1659x2212.
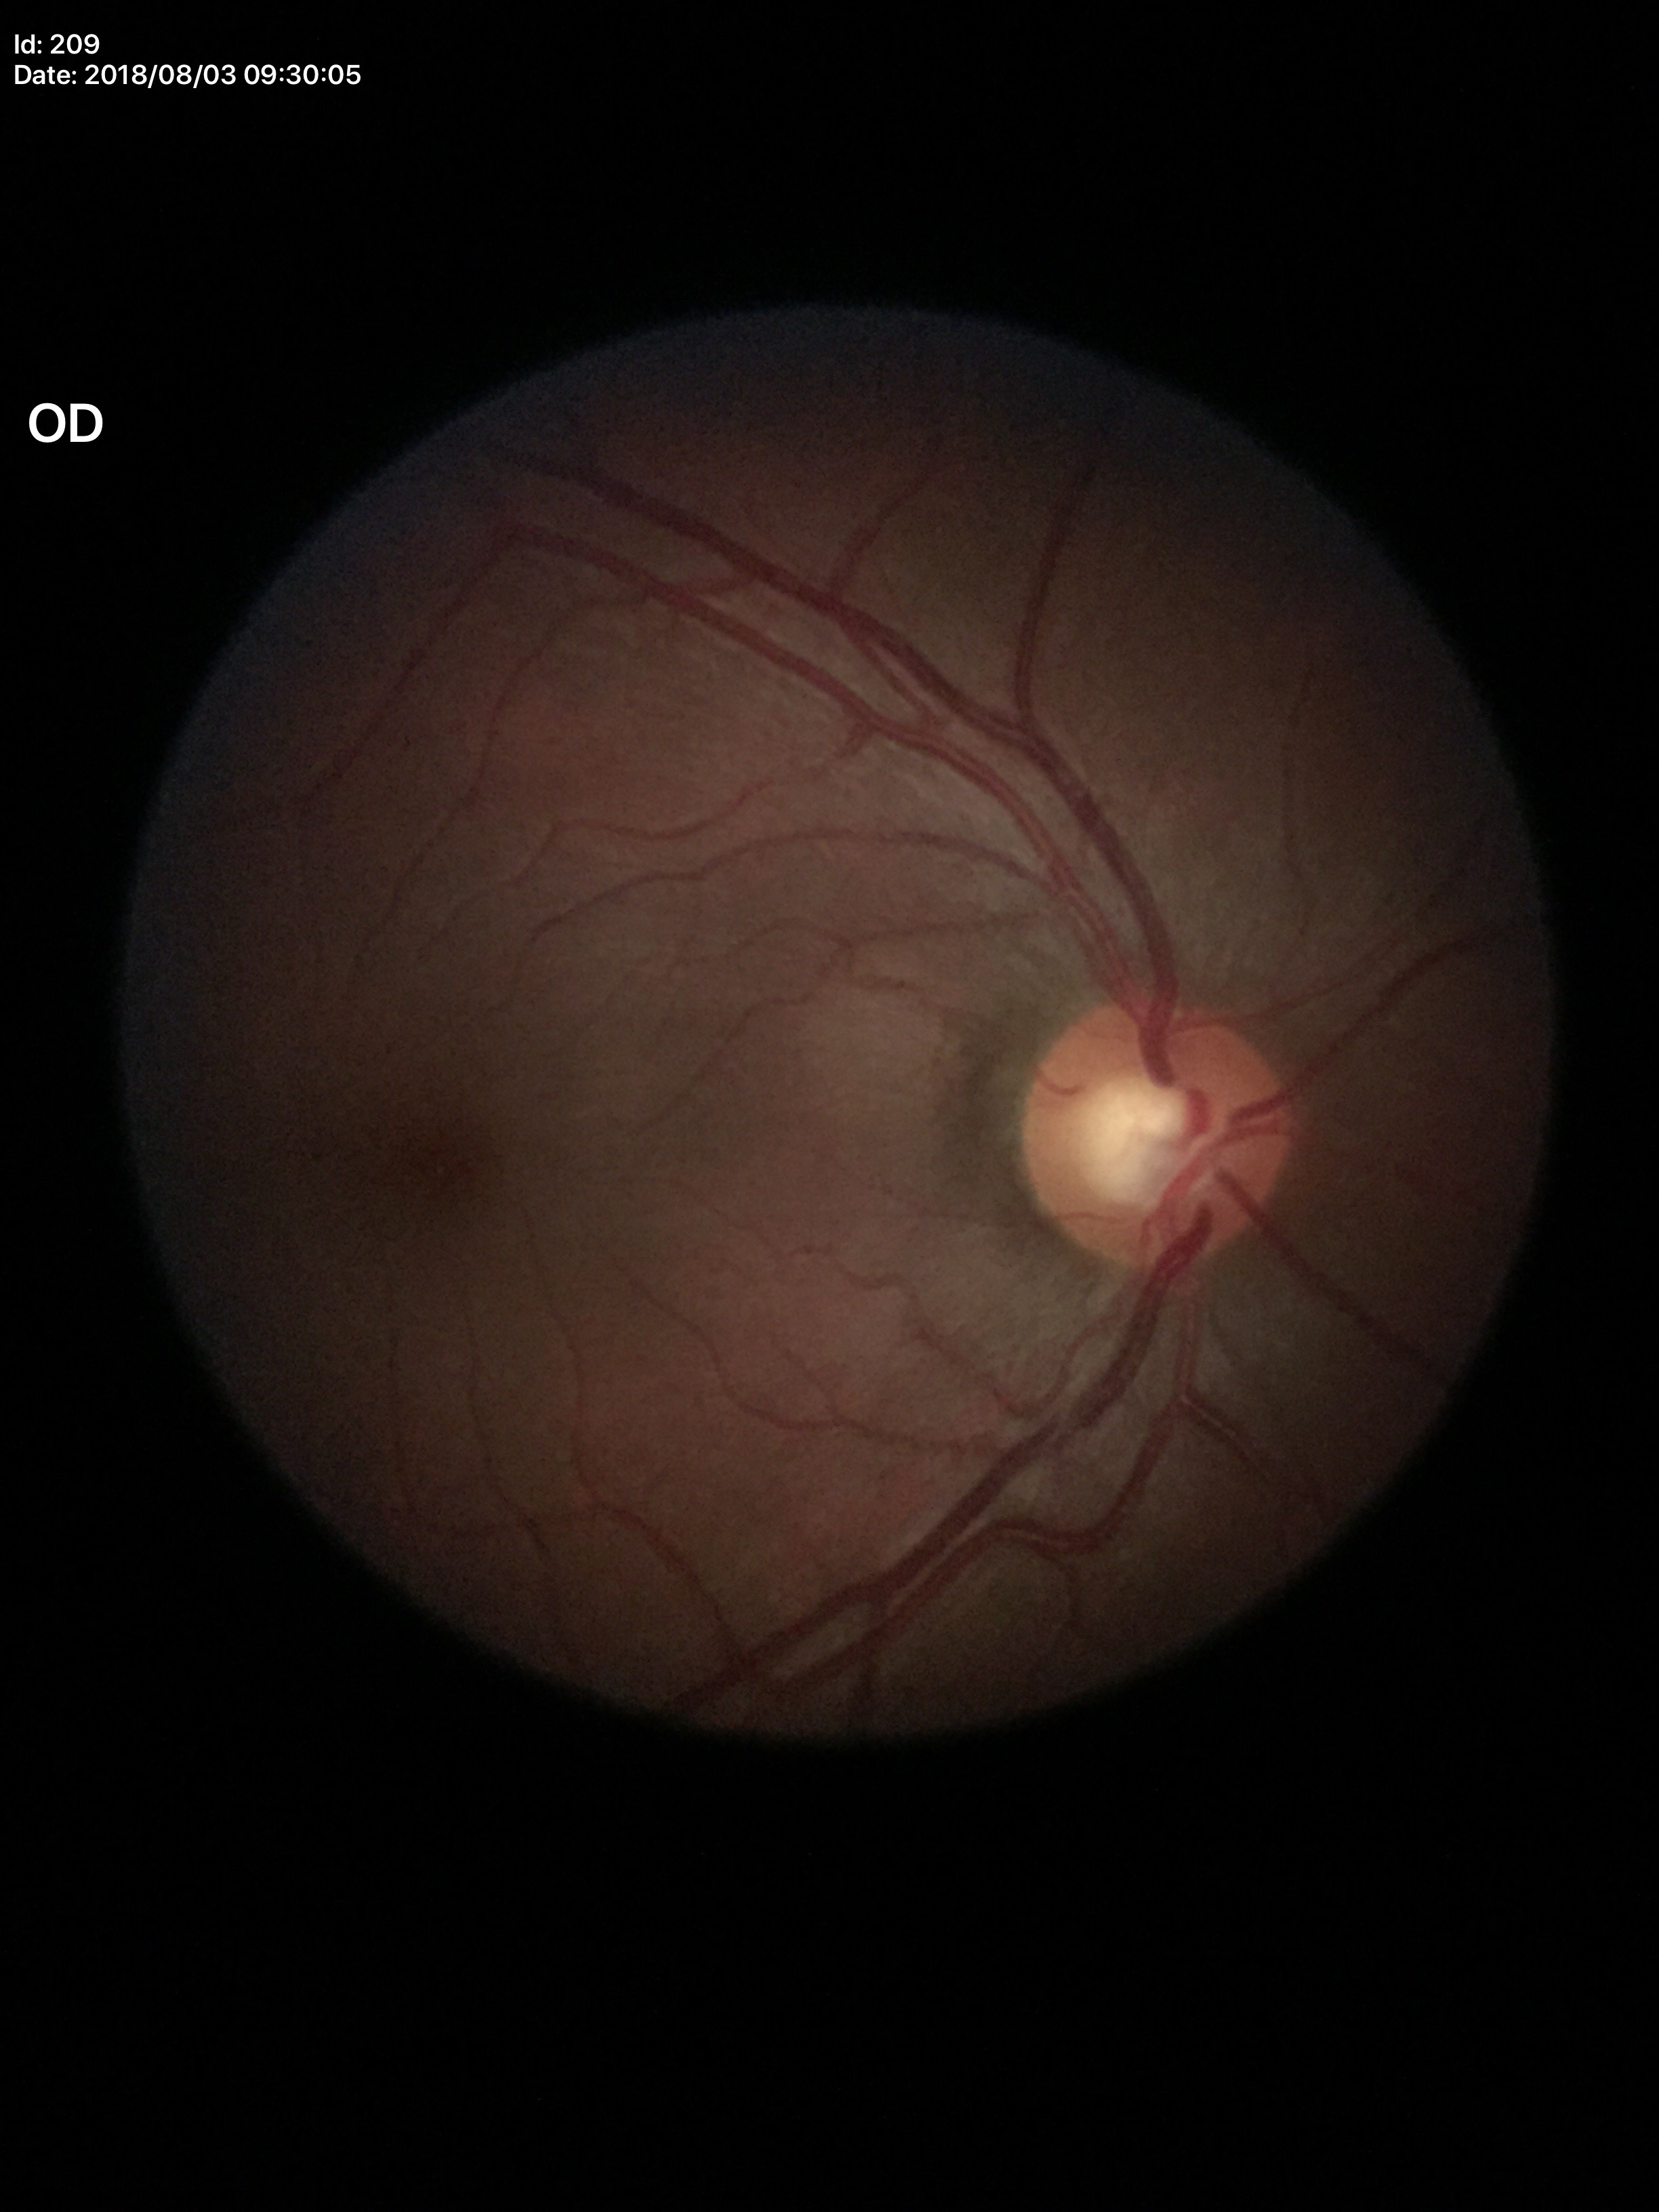   glaucoma_decision: not suspect (5/5 ophthalmologists in agreement)
  vcdr: 0.52